Modified Davis grading — 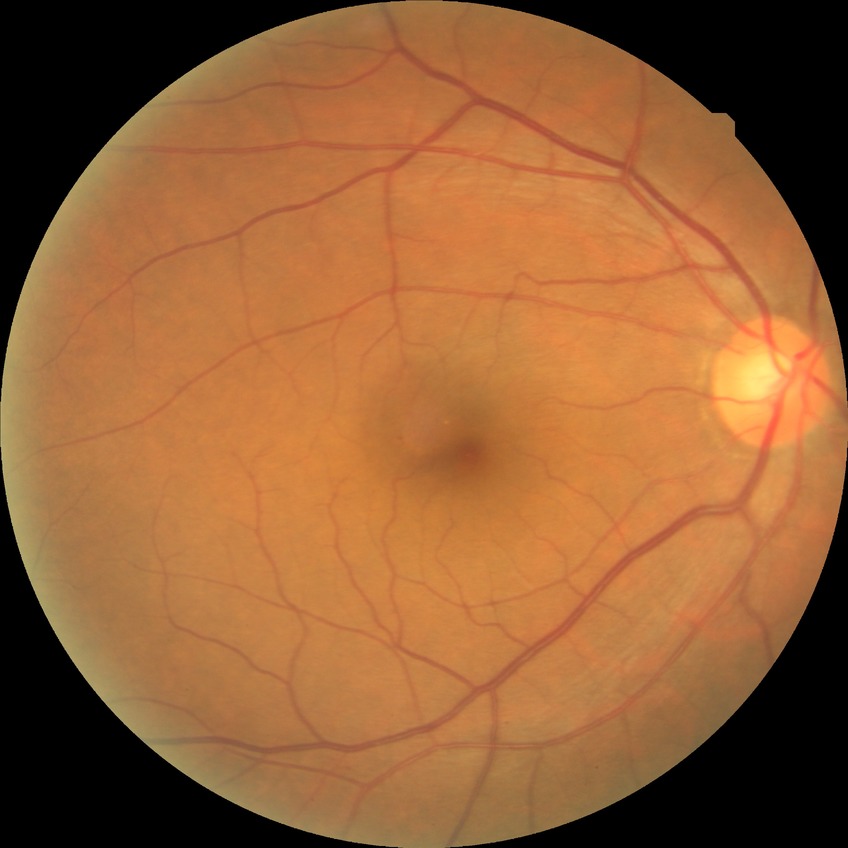 davis_grade: no diabetic retinopathy